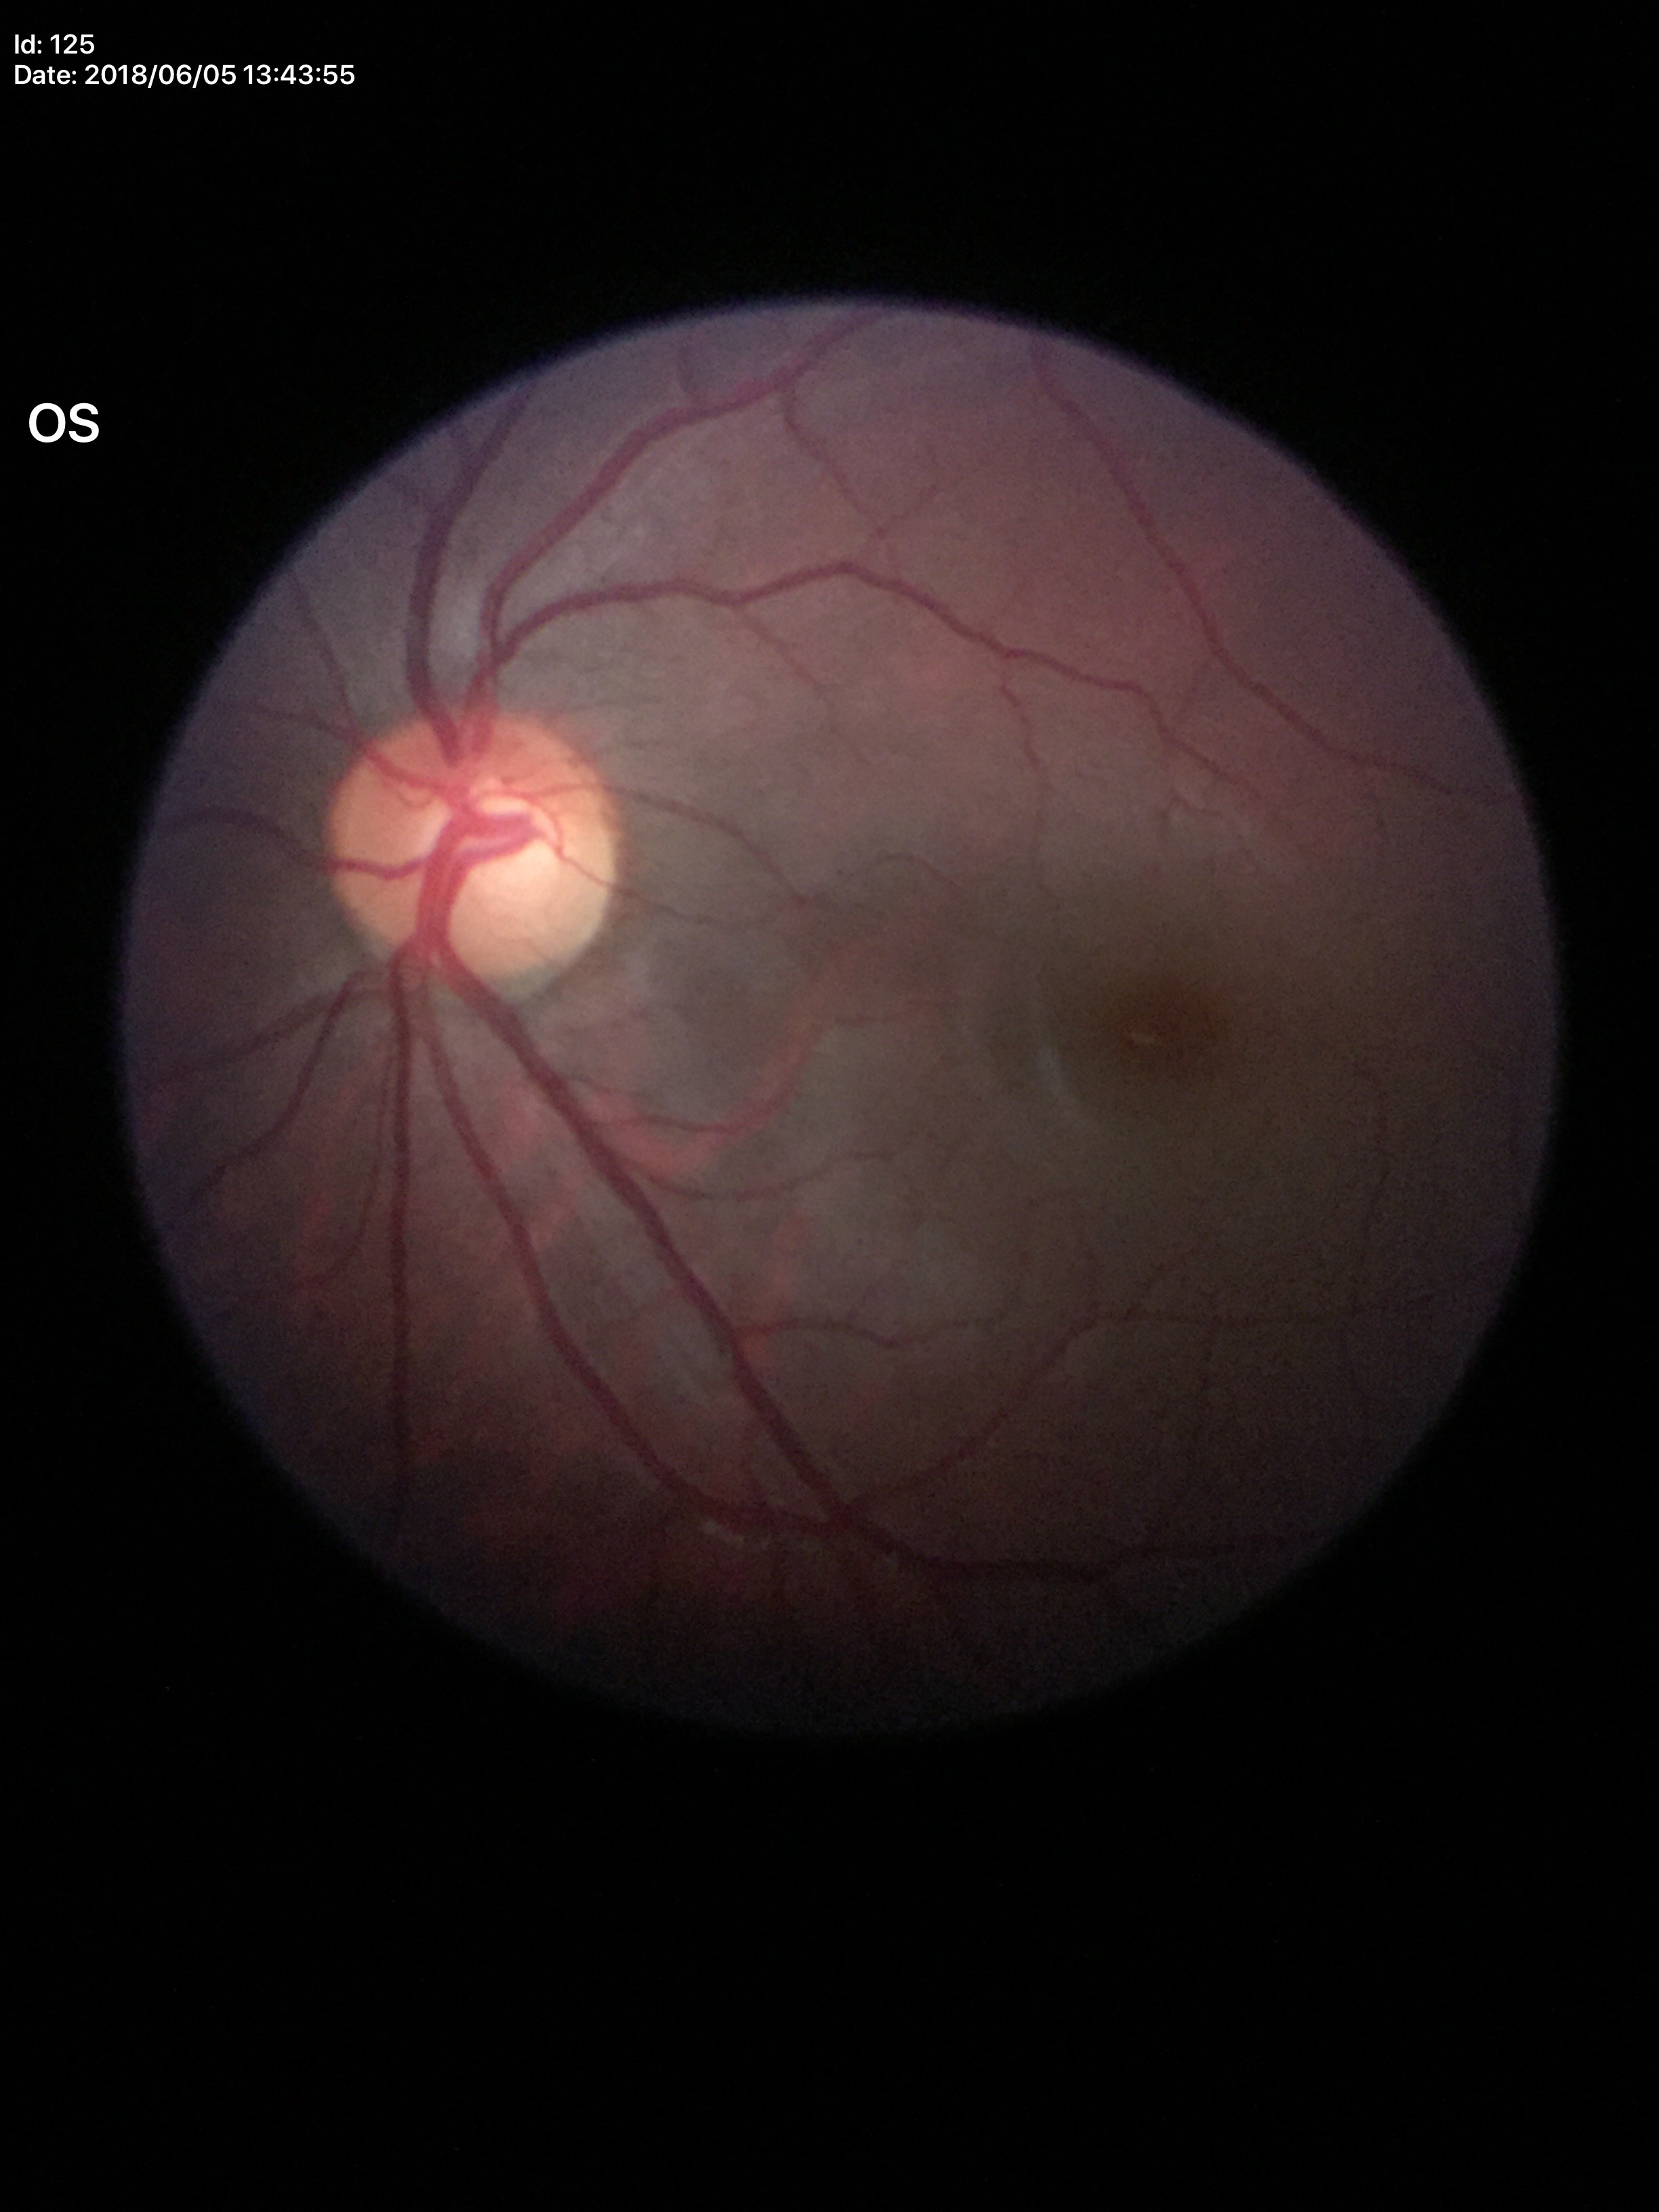

Glaucoma screening: negative; vertical C/D ratio: 0.53; horizontal cup-to-disc ratio: 0.55.